Centered on the macula; 2361x1568; camera: Kowa VX-10α
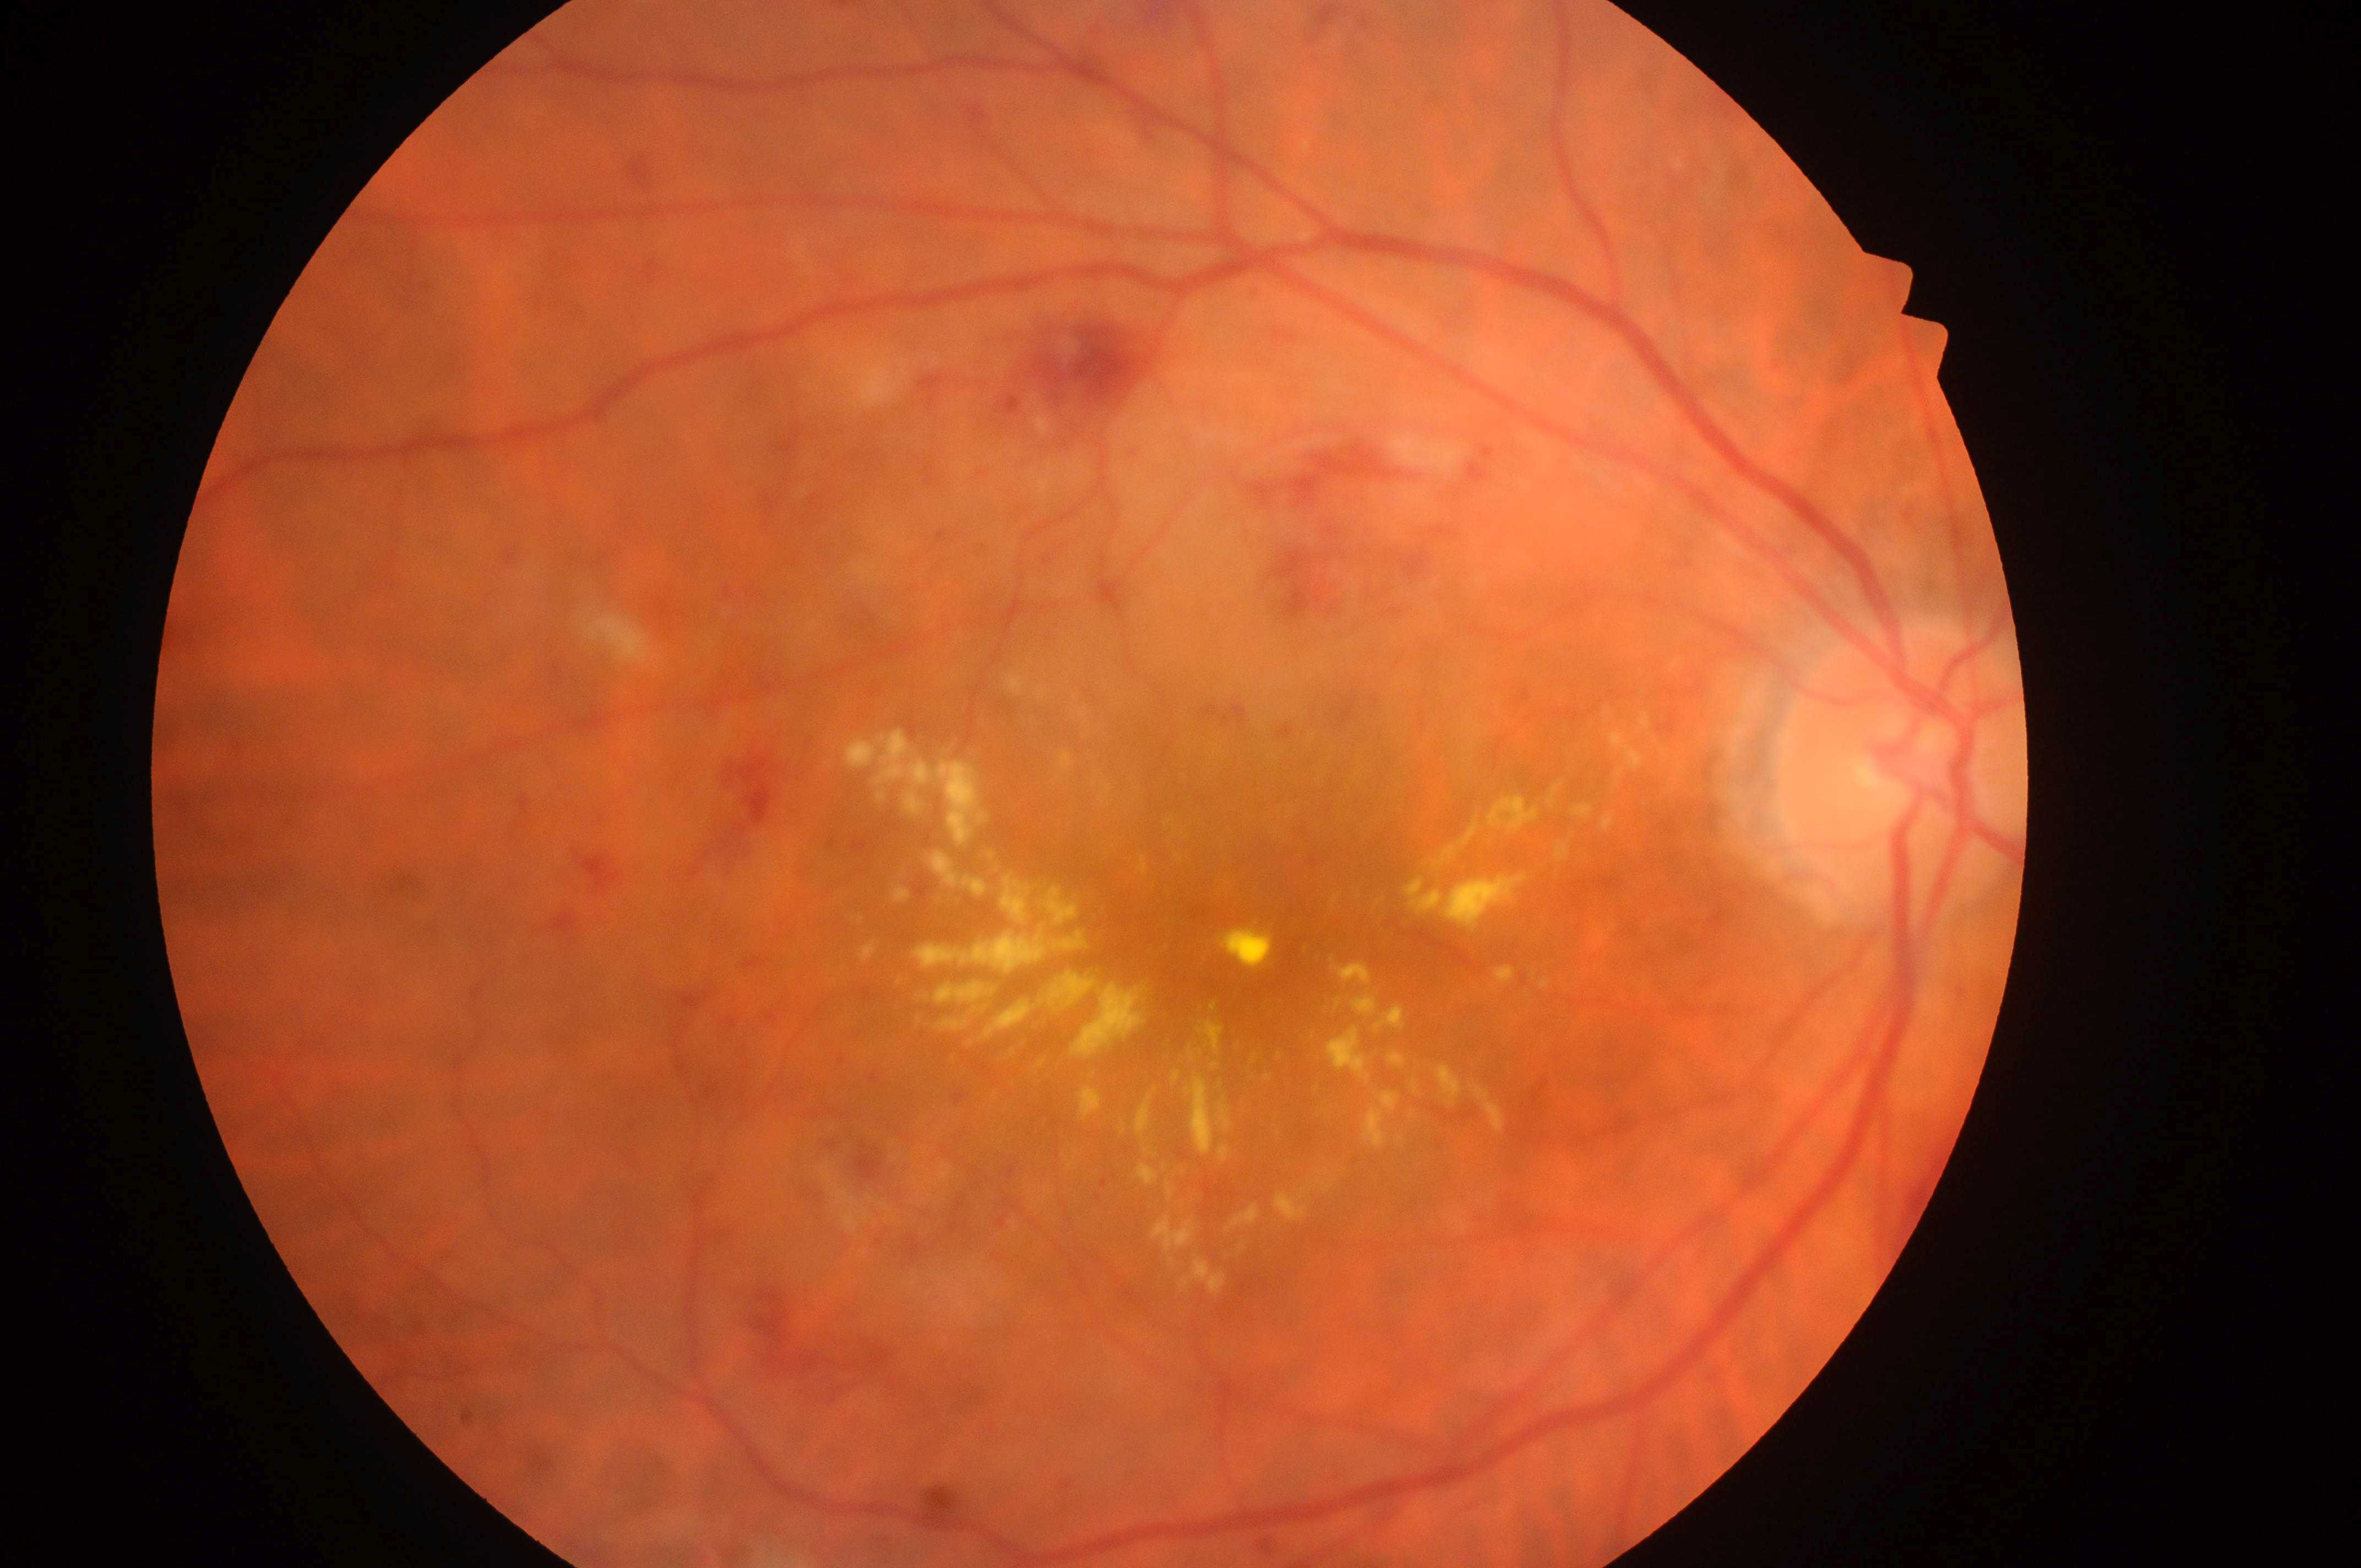
Macular edema: 2/2 — hard exudates within one disc diameter of the macula center. The ONH is at (x=1914, y=777). Retinopathy grade: 3/4 — more than 20 intraretinal hemorrhages in each of 4 quadrants, definite venous beading in 2 or more quadrants, or prominent intraretinal microvascular abnormalities in 1 or more quadrants, with no signs of proliferative retinopathy. Fovea located at (x=1264, y=919). Eye: right.